Nonmydriatic fundus photograph
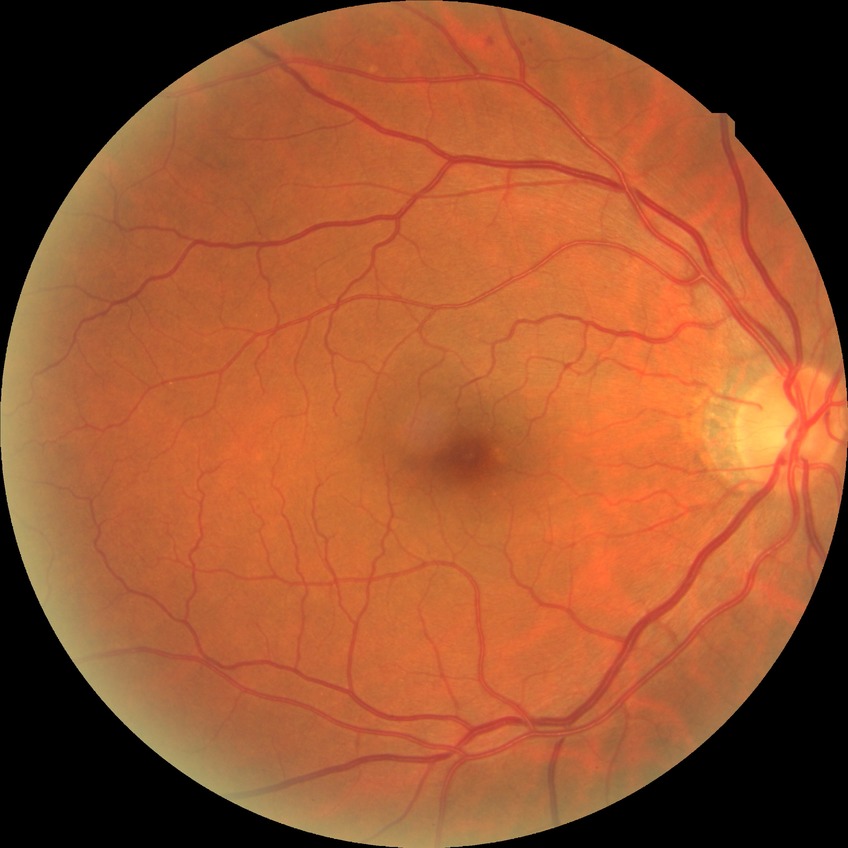
diabetic retinopathy (DR): SDR (simple diabetic retinopathy).